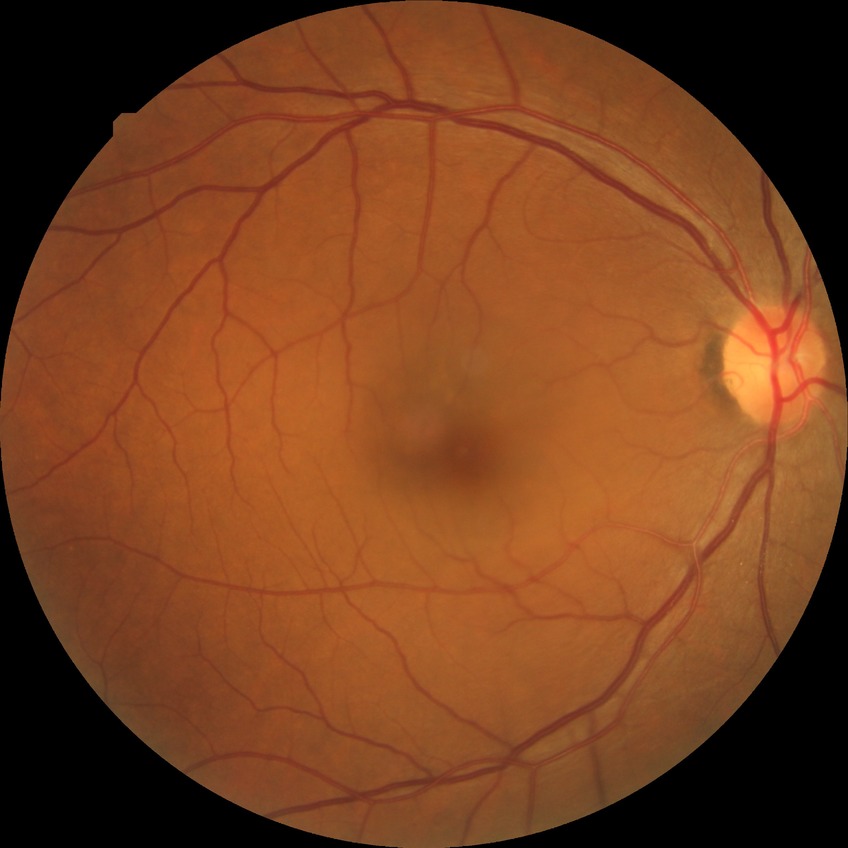

Diabetic retinopathy severity is no diabetic retinopathy.